1240x1240px; 100° field of view (Phoenix ICON); pediatric retinal photograph (wide-field) — 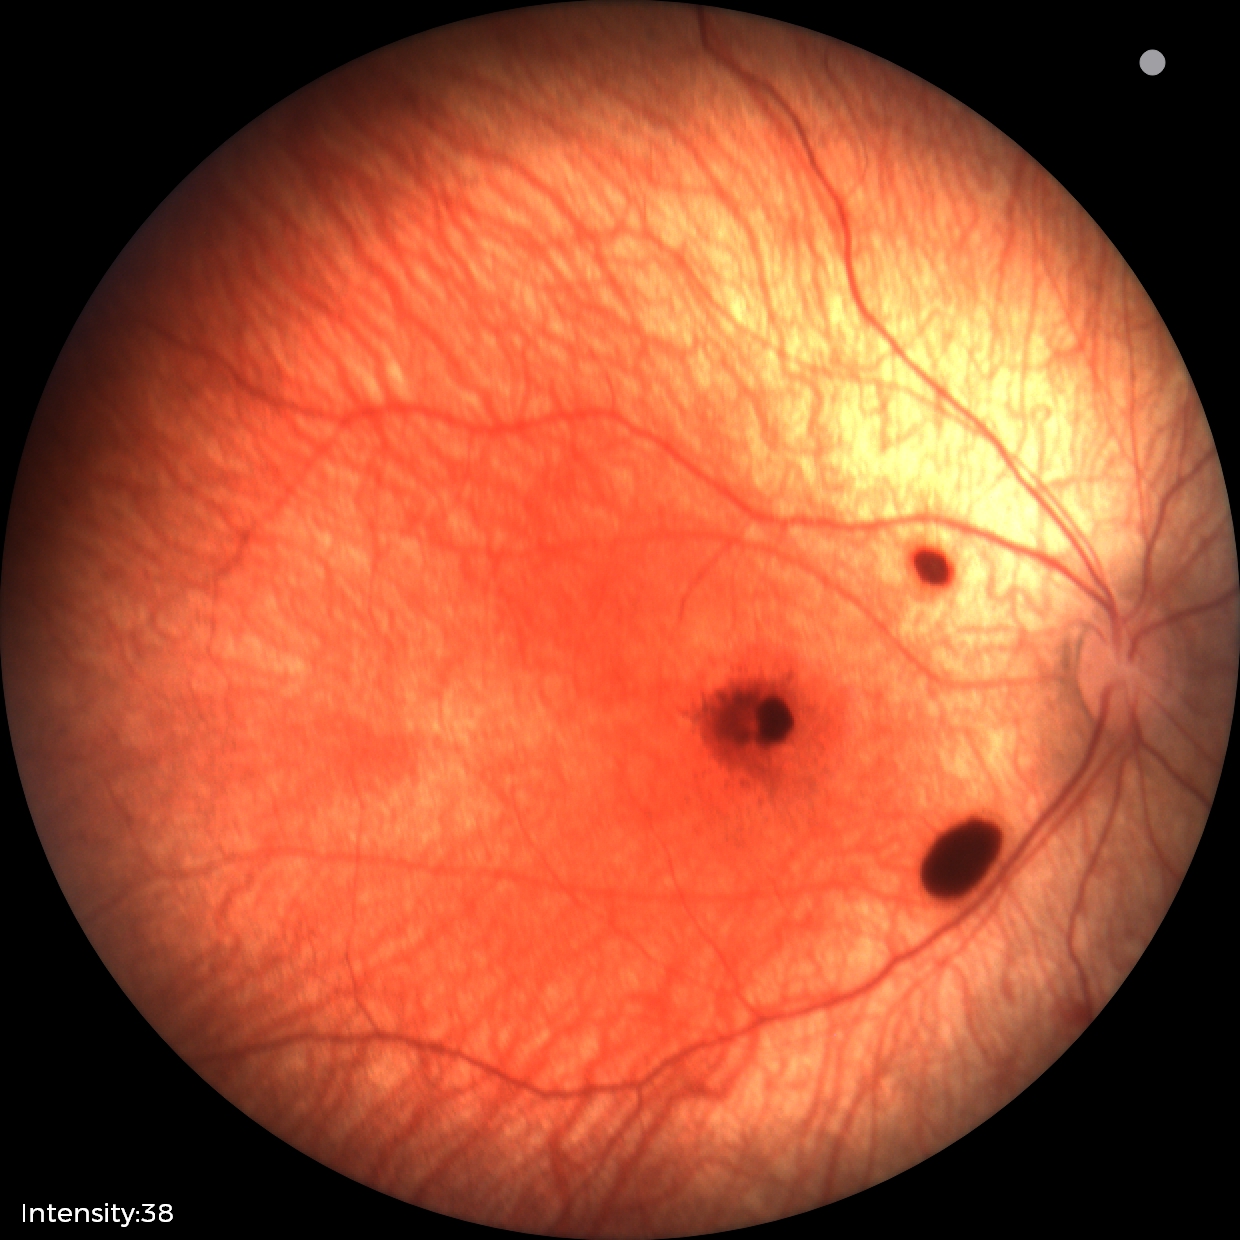

Assessment: retinal hemorrhages.